Image size 640x480 · wide-field contact fundus photograph of an infant.
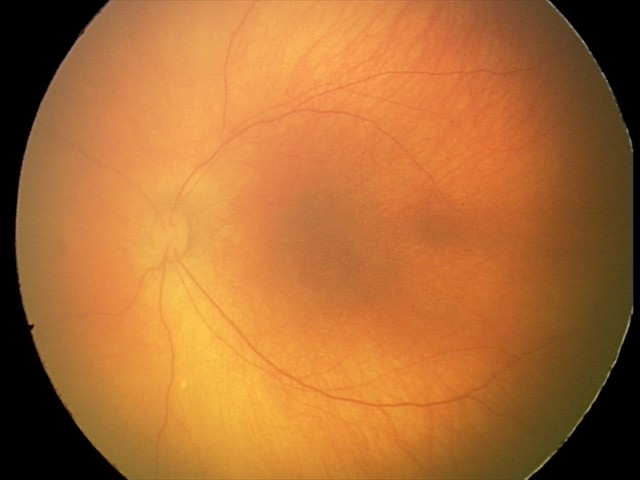 Physiological retinal appearance for postconceptual age.